Pediatric retinal photograph (wide-field): 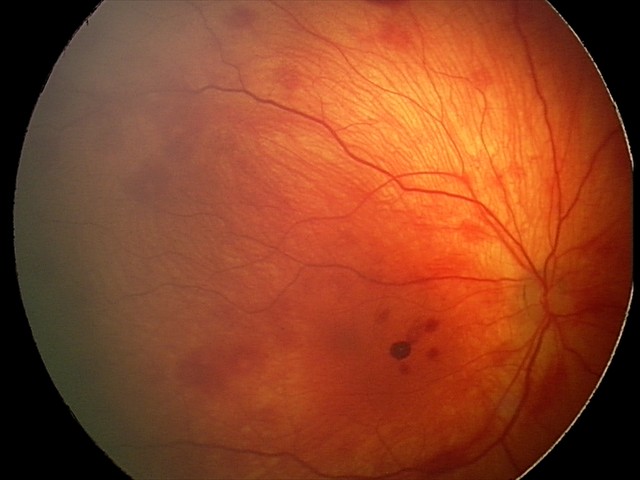

Screening examination consistent with retinal hemorrhages.